NIDEK AFC-230 fundus camera; without pupil dilation; modified Davis grading — 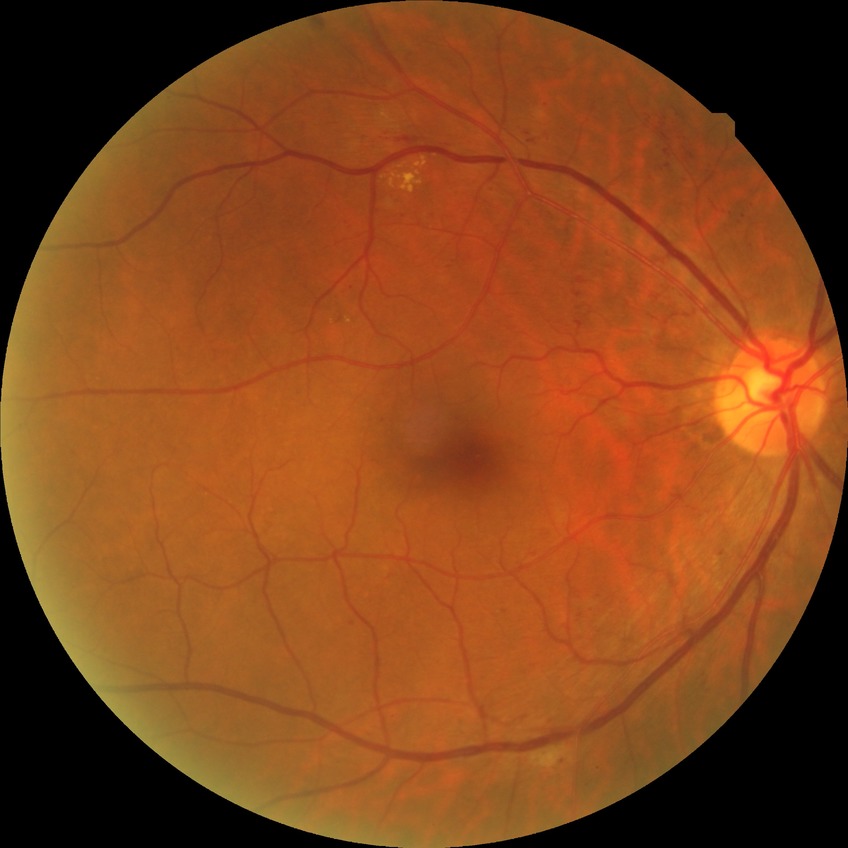
Modified Davis grading is pre-proliferative diabetic retinopathy.